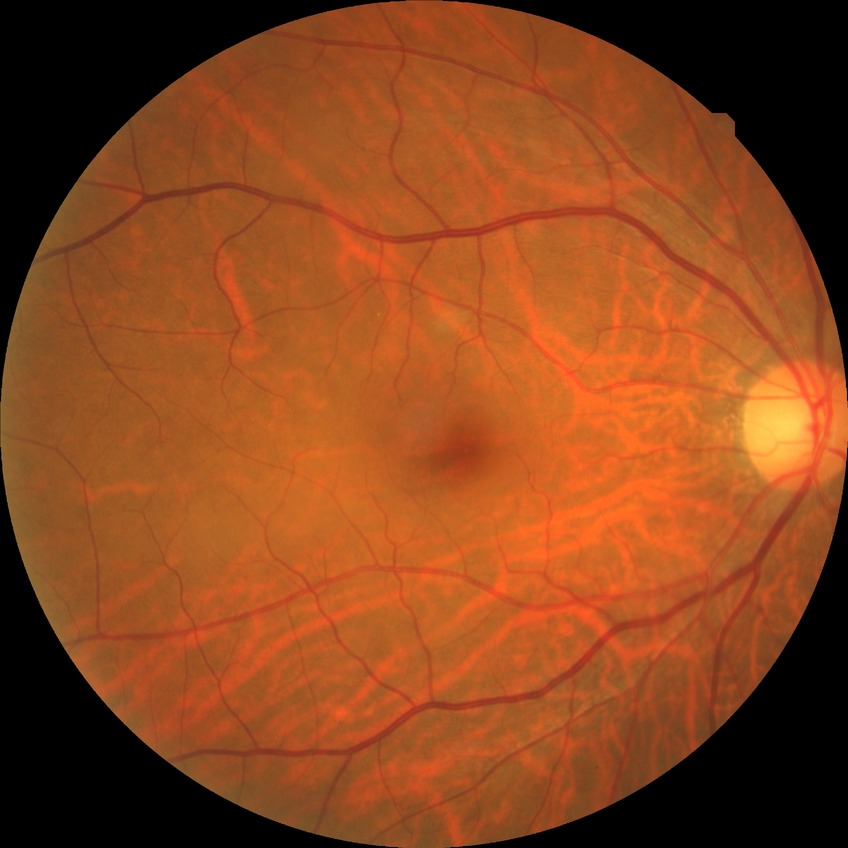 Disease class: non-proliferative diabetic retinopathy. Davis grading: simple diabetic retinopathy.